45-degree field of view; fundus photo; 2048 x 1536 pixels — 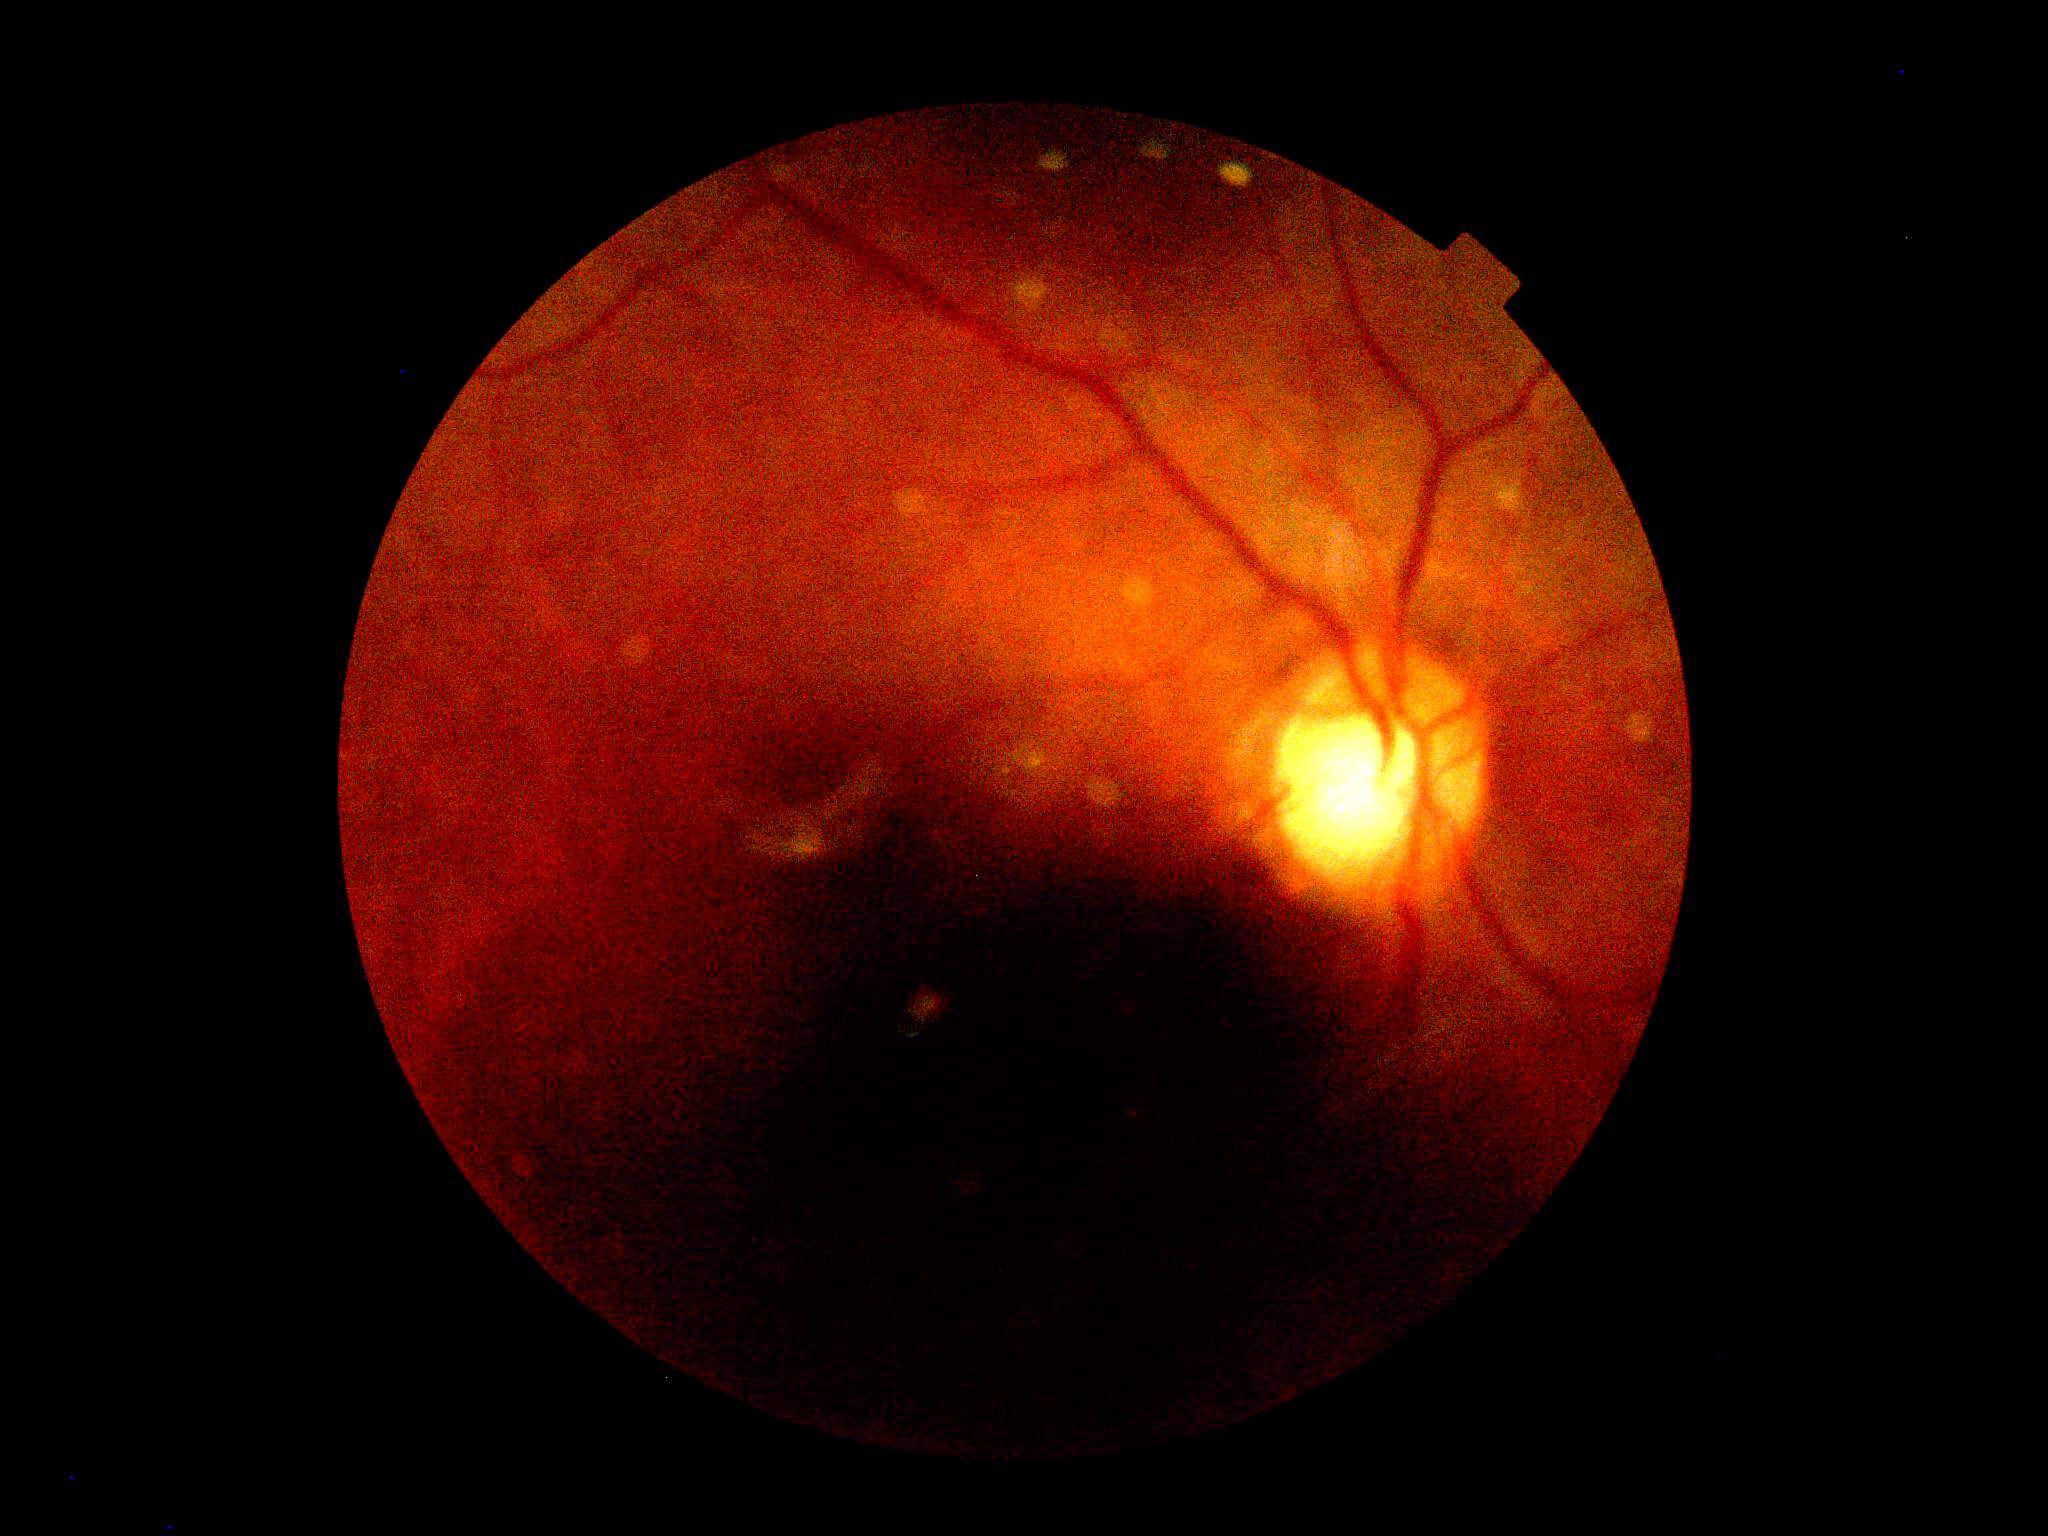

DR stage is ungradable.